Wide-field fundus photograph of an infant. Captured with the Natus RetCam Envision (130° field of view)
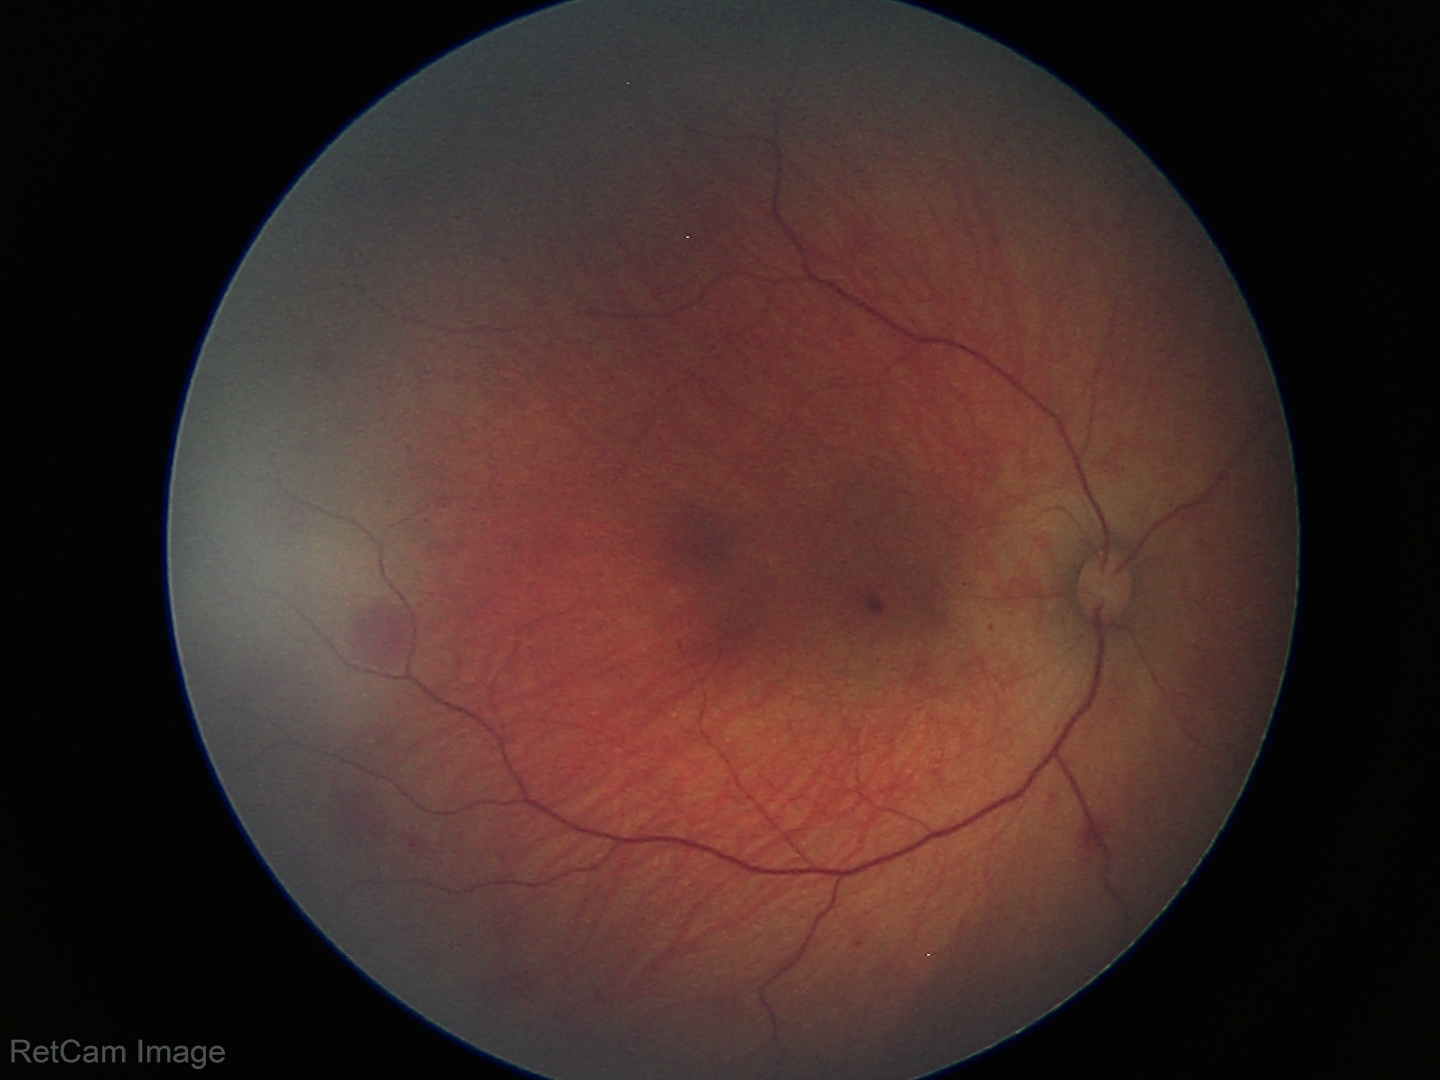 Screening diagnosis: retinal hemorrhages.